Without pupil dilation · NIDEK AFC-230 · modified Davis grading
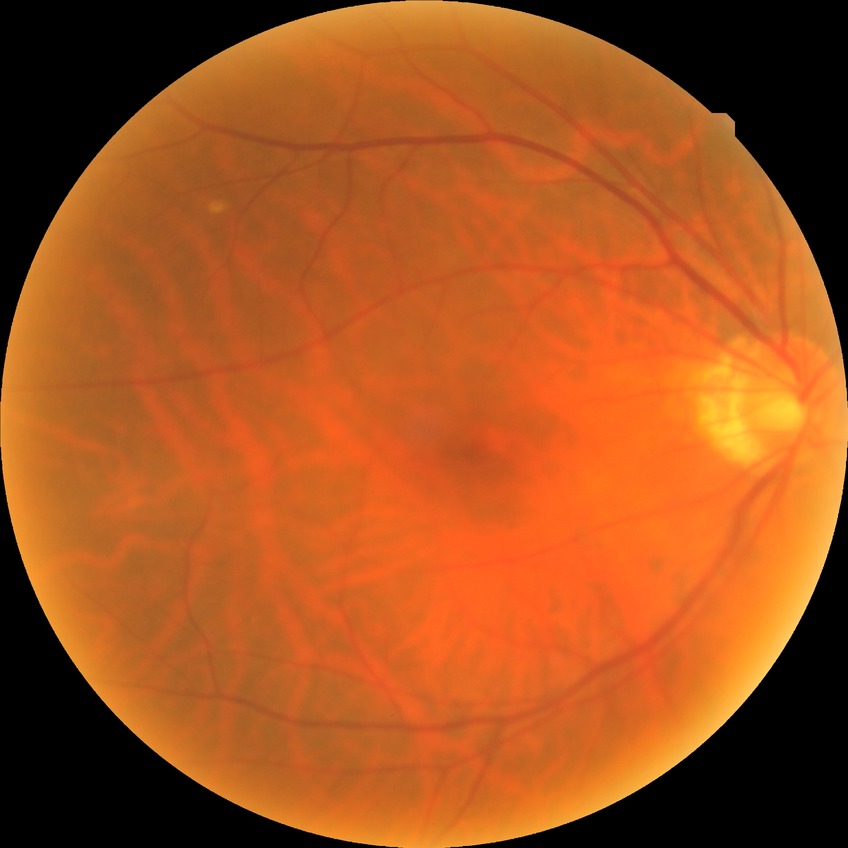

diabetic retinopathy (DR): NDR (no diabetic retinopathy).